Wide-field fundus photograph from neonatal ROP screening:
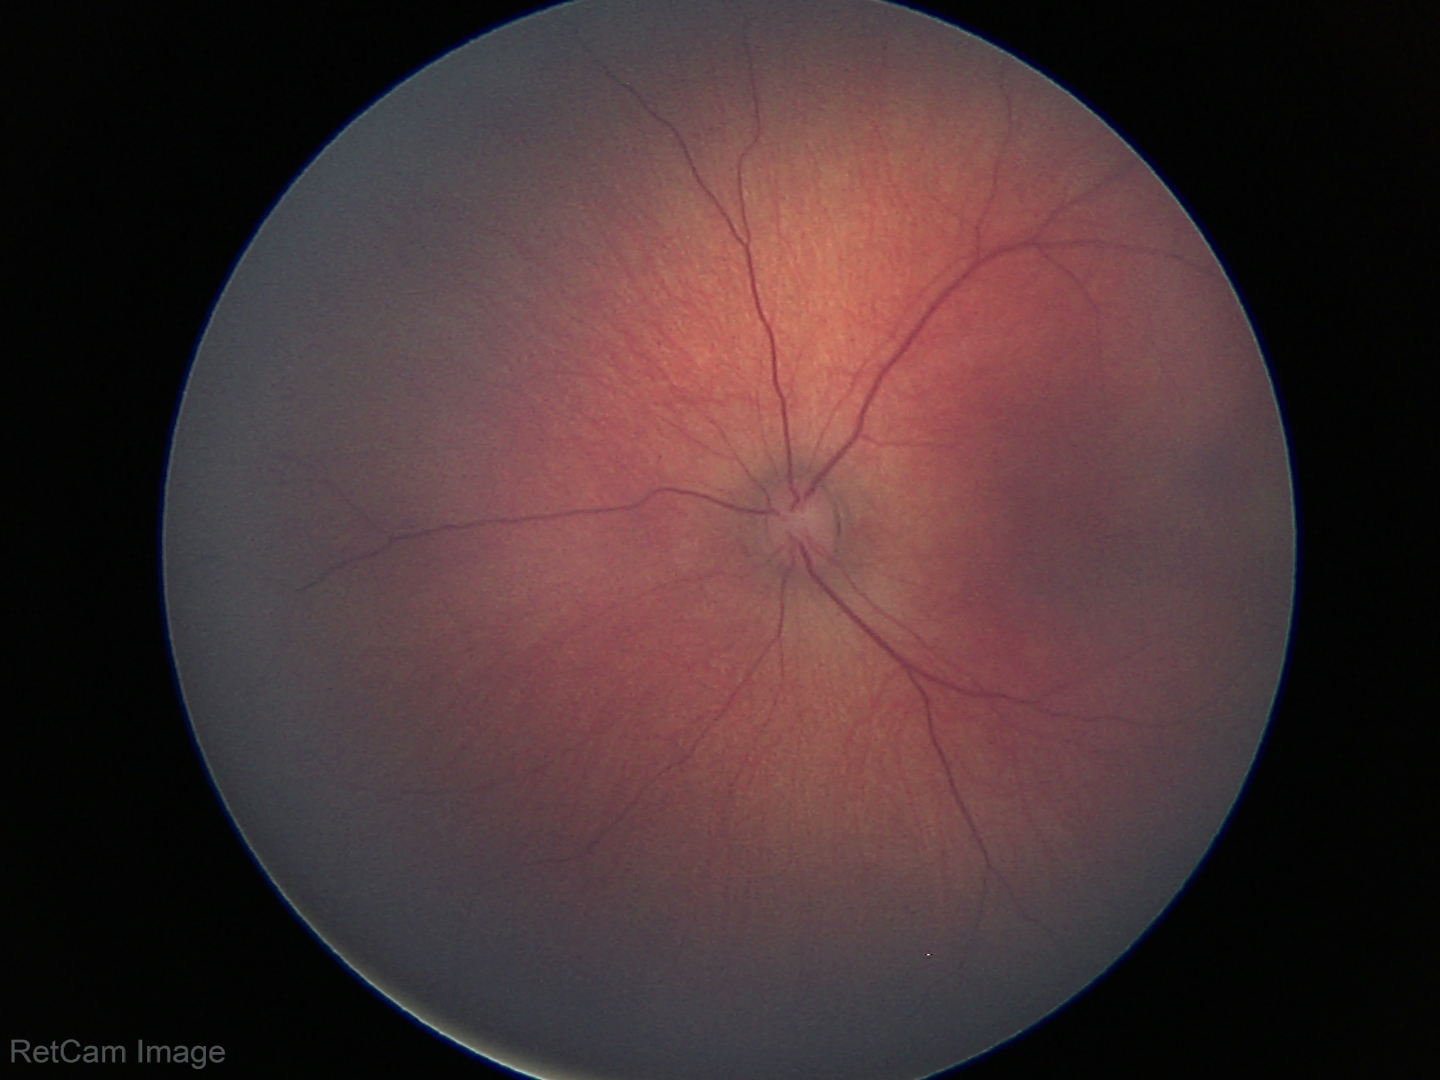 Assessment: physiological appearance with no retinal pathology.